Retinal fundus photograph — 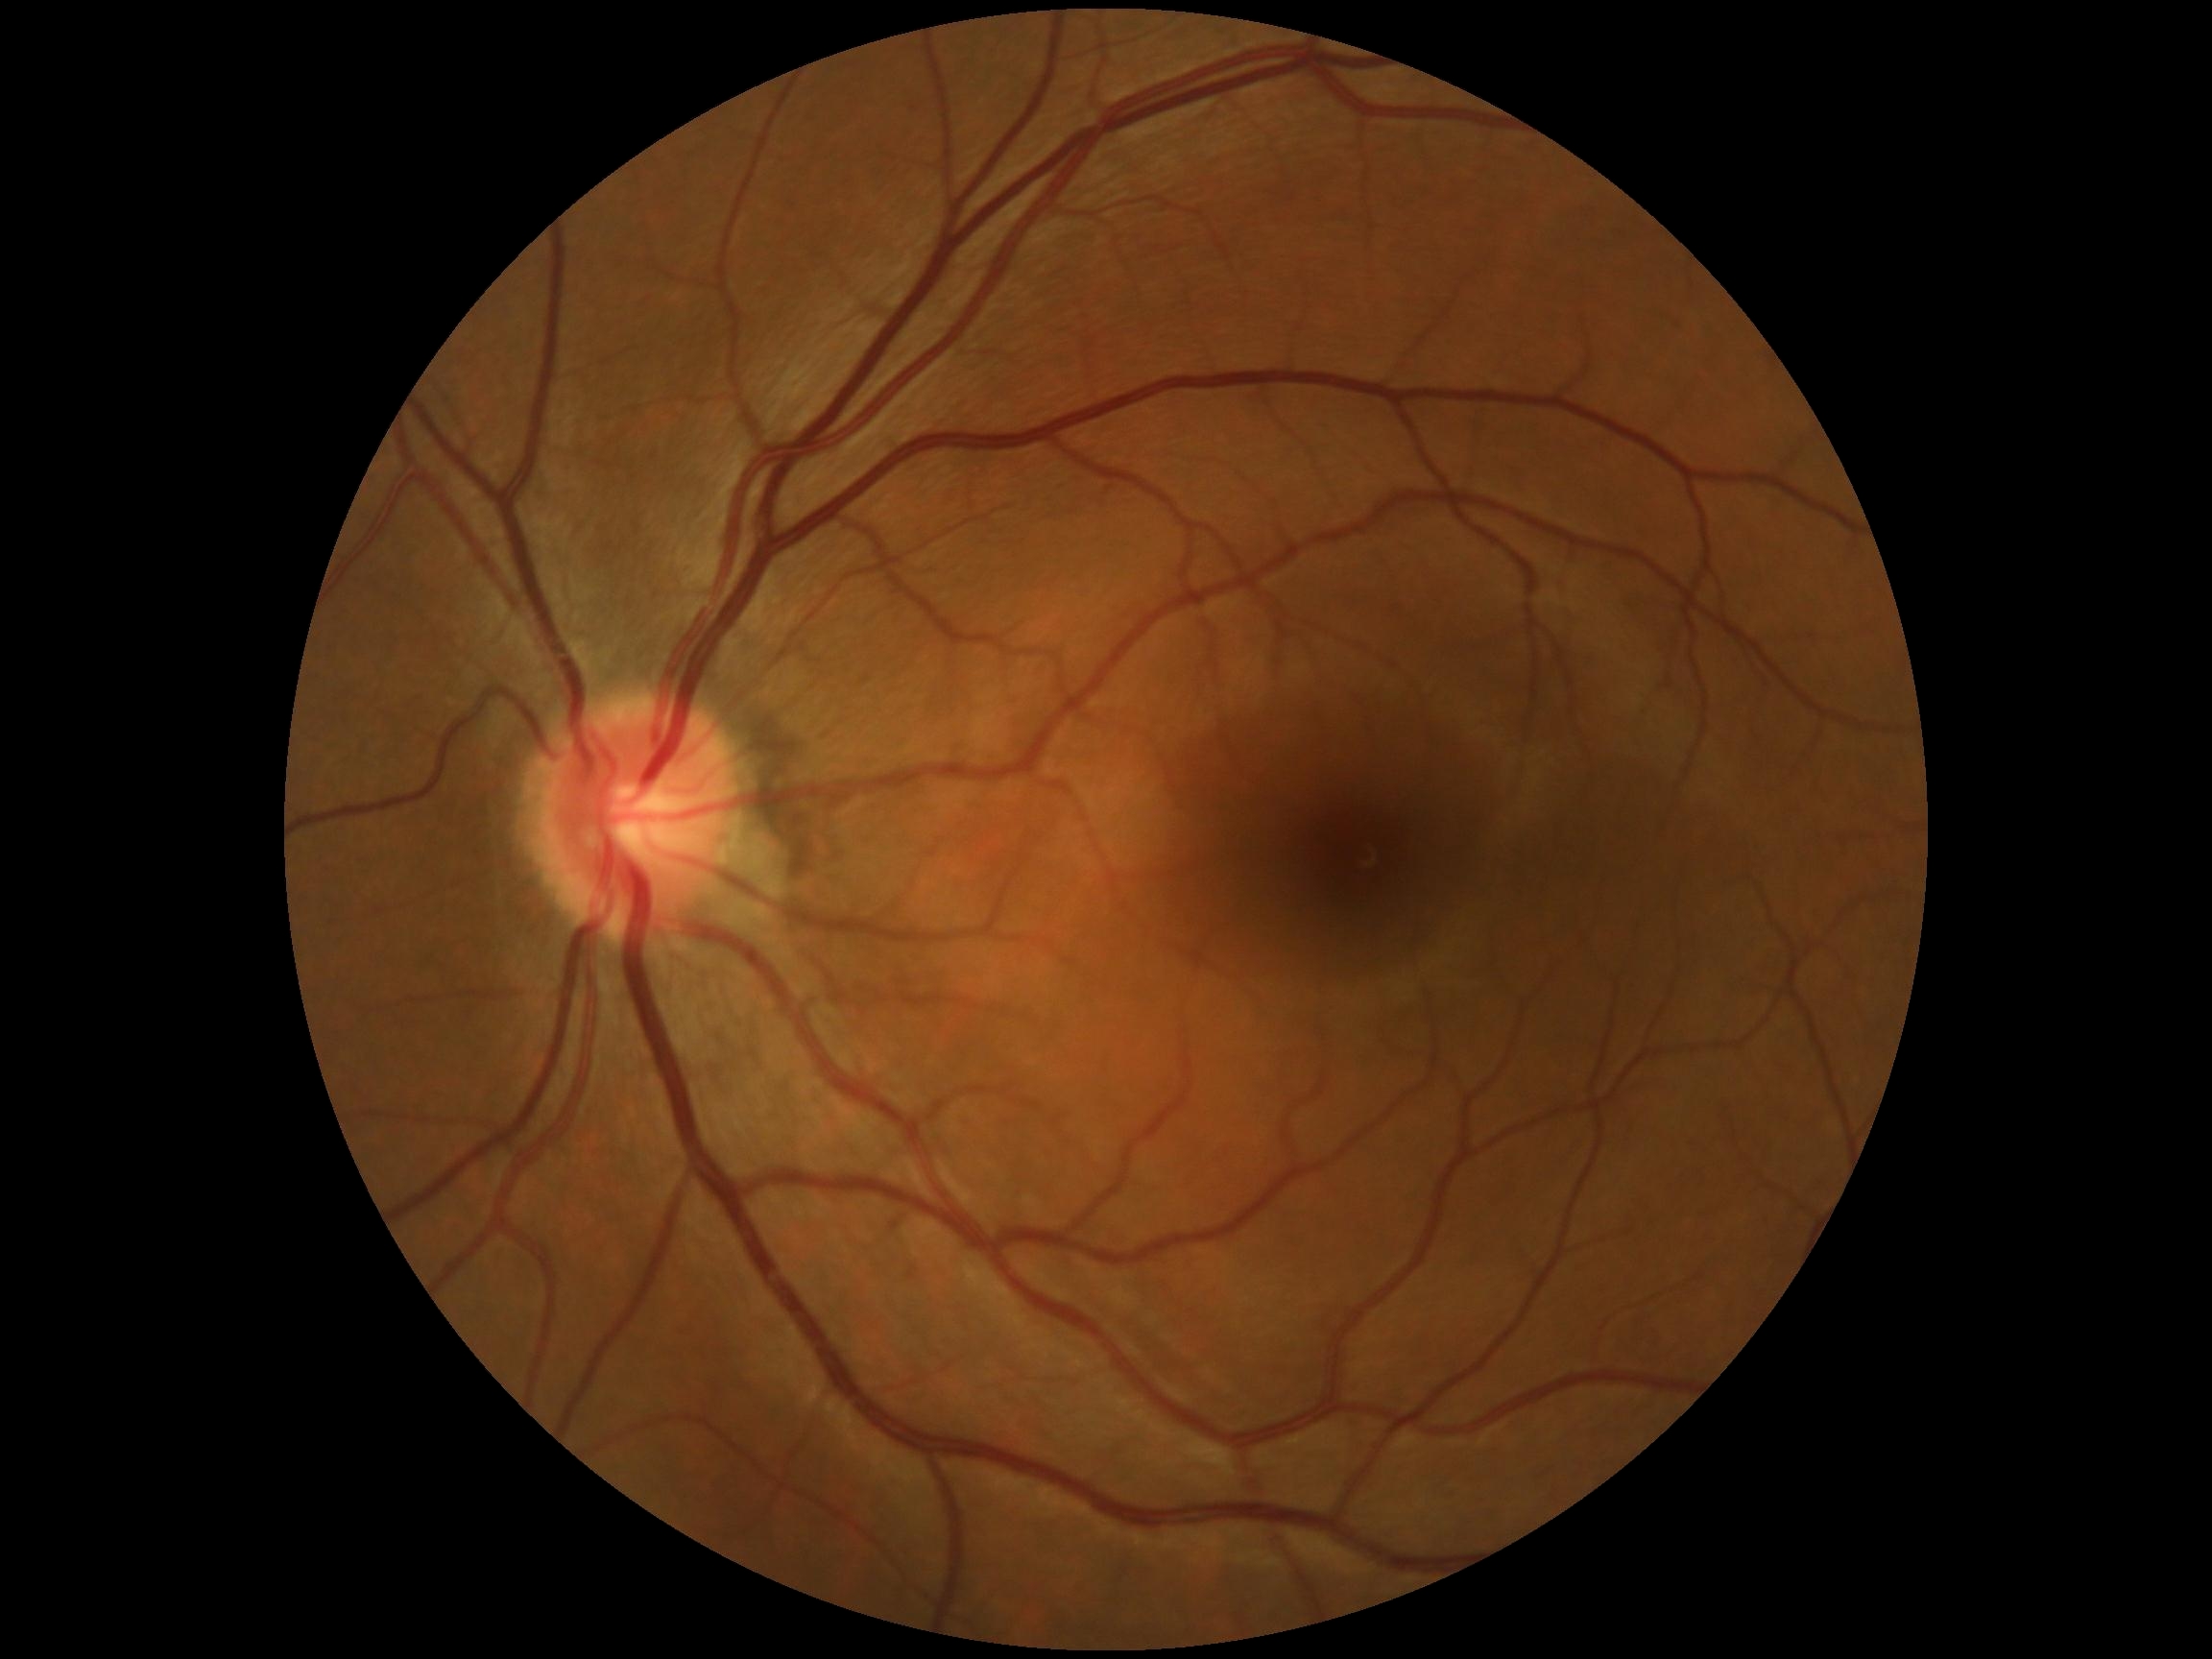 DR severity: no apparent retinopathy (grade 0).